Wide-field fundus photograph from neonatal ROP screening · 1440x1080px:
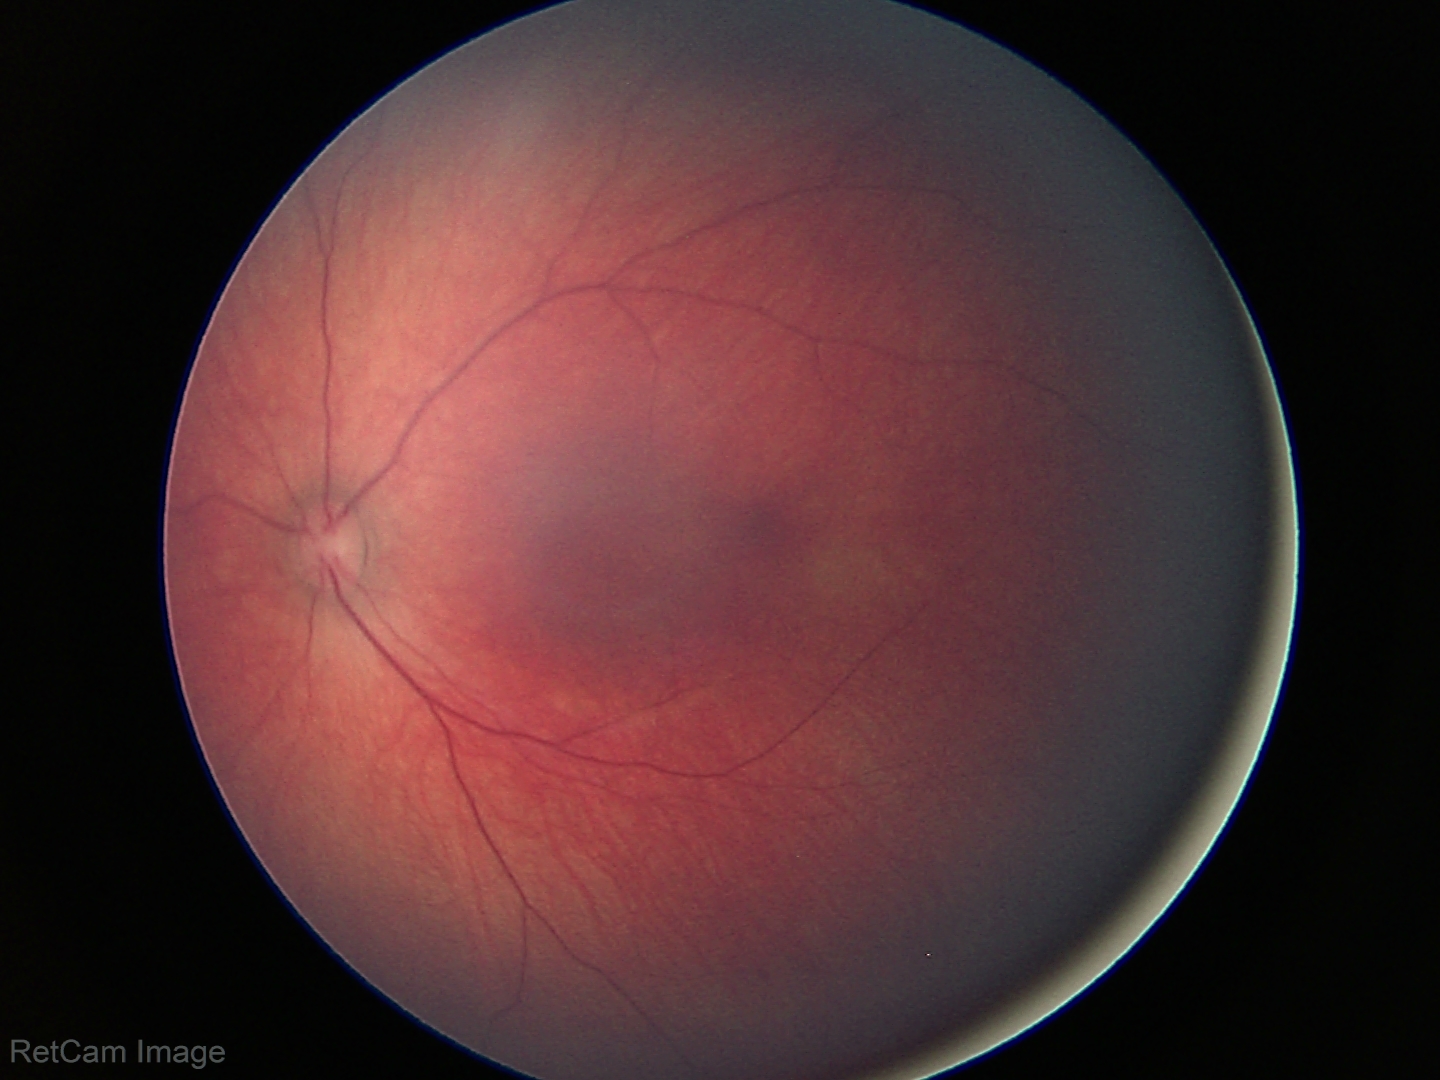
Screening diagnosis = physiological appearance.